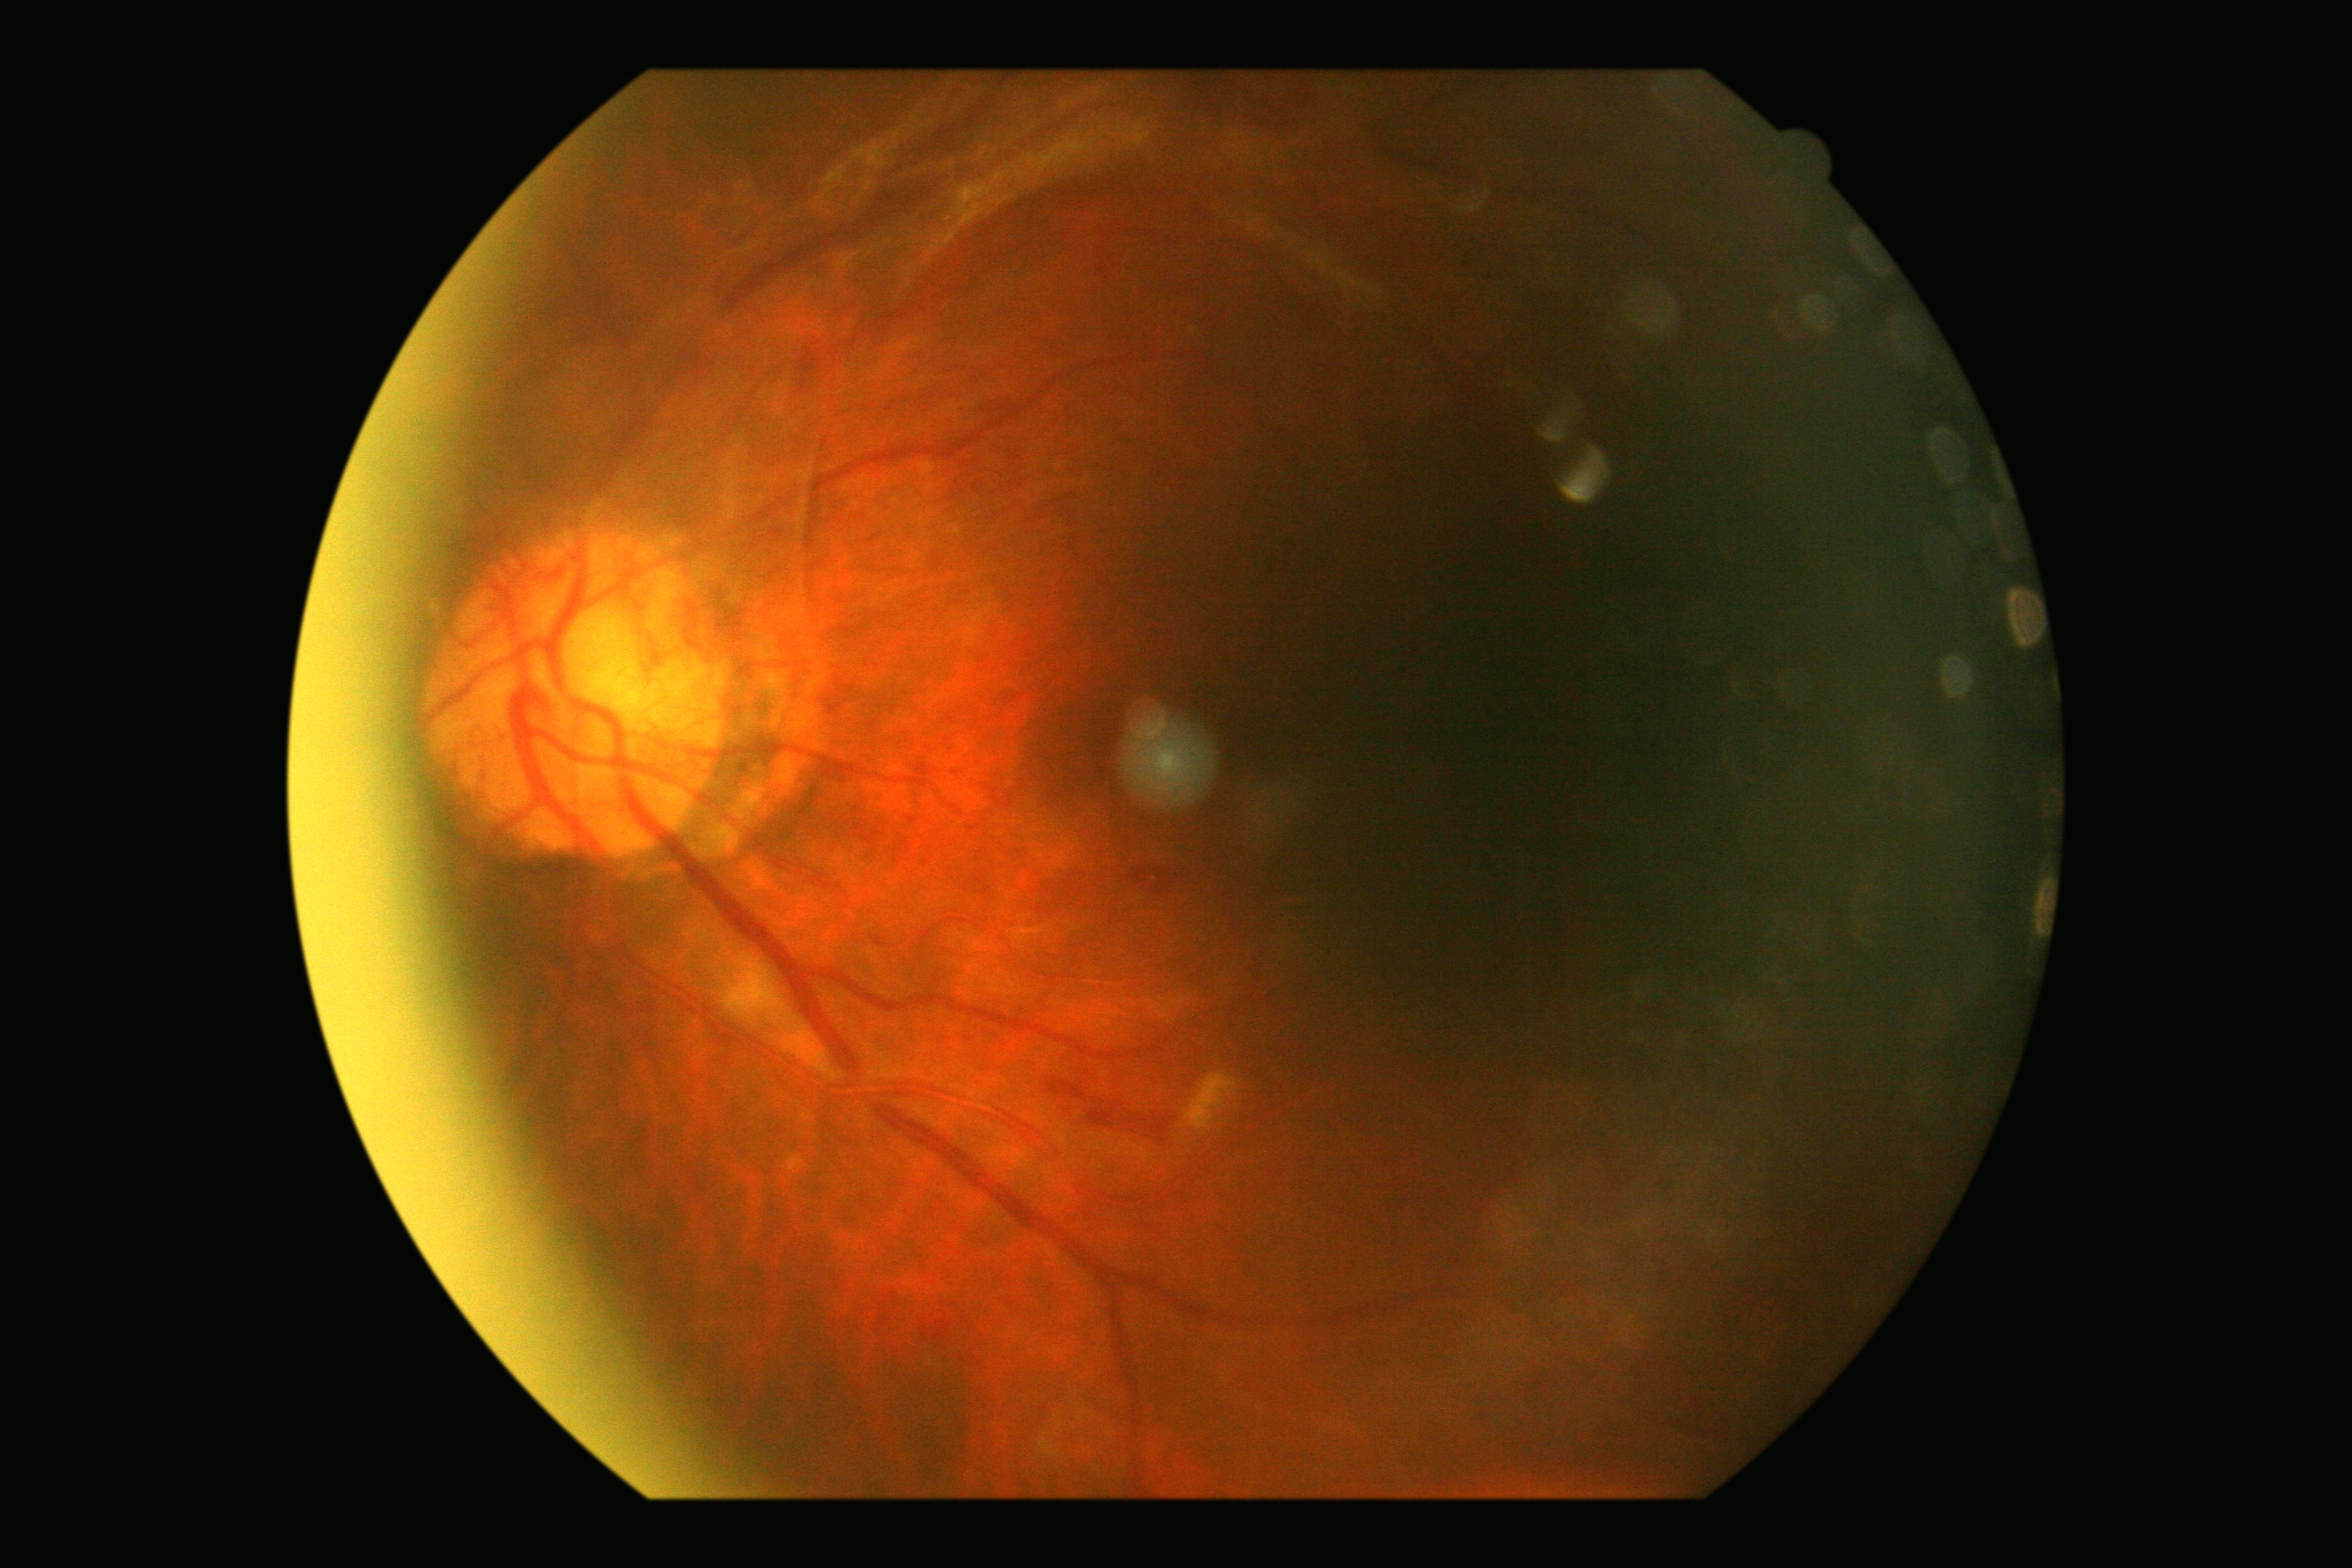

Diabetic retinopathy grade is 4/4.